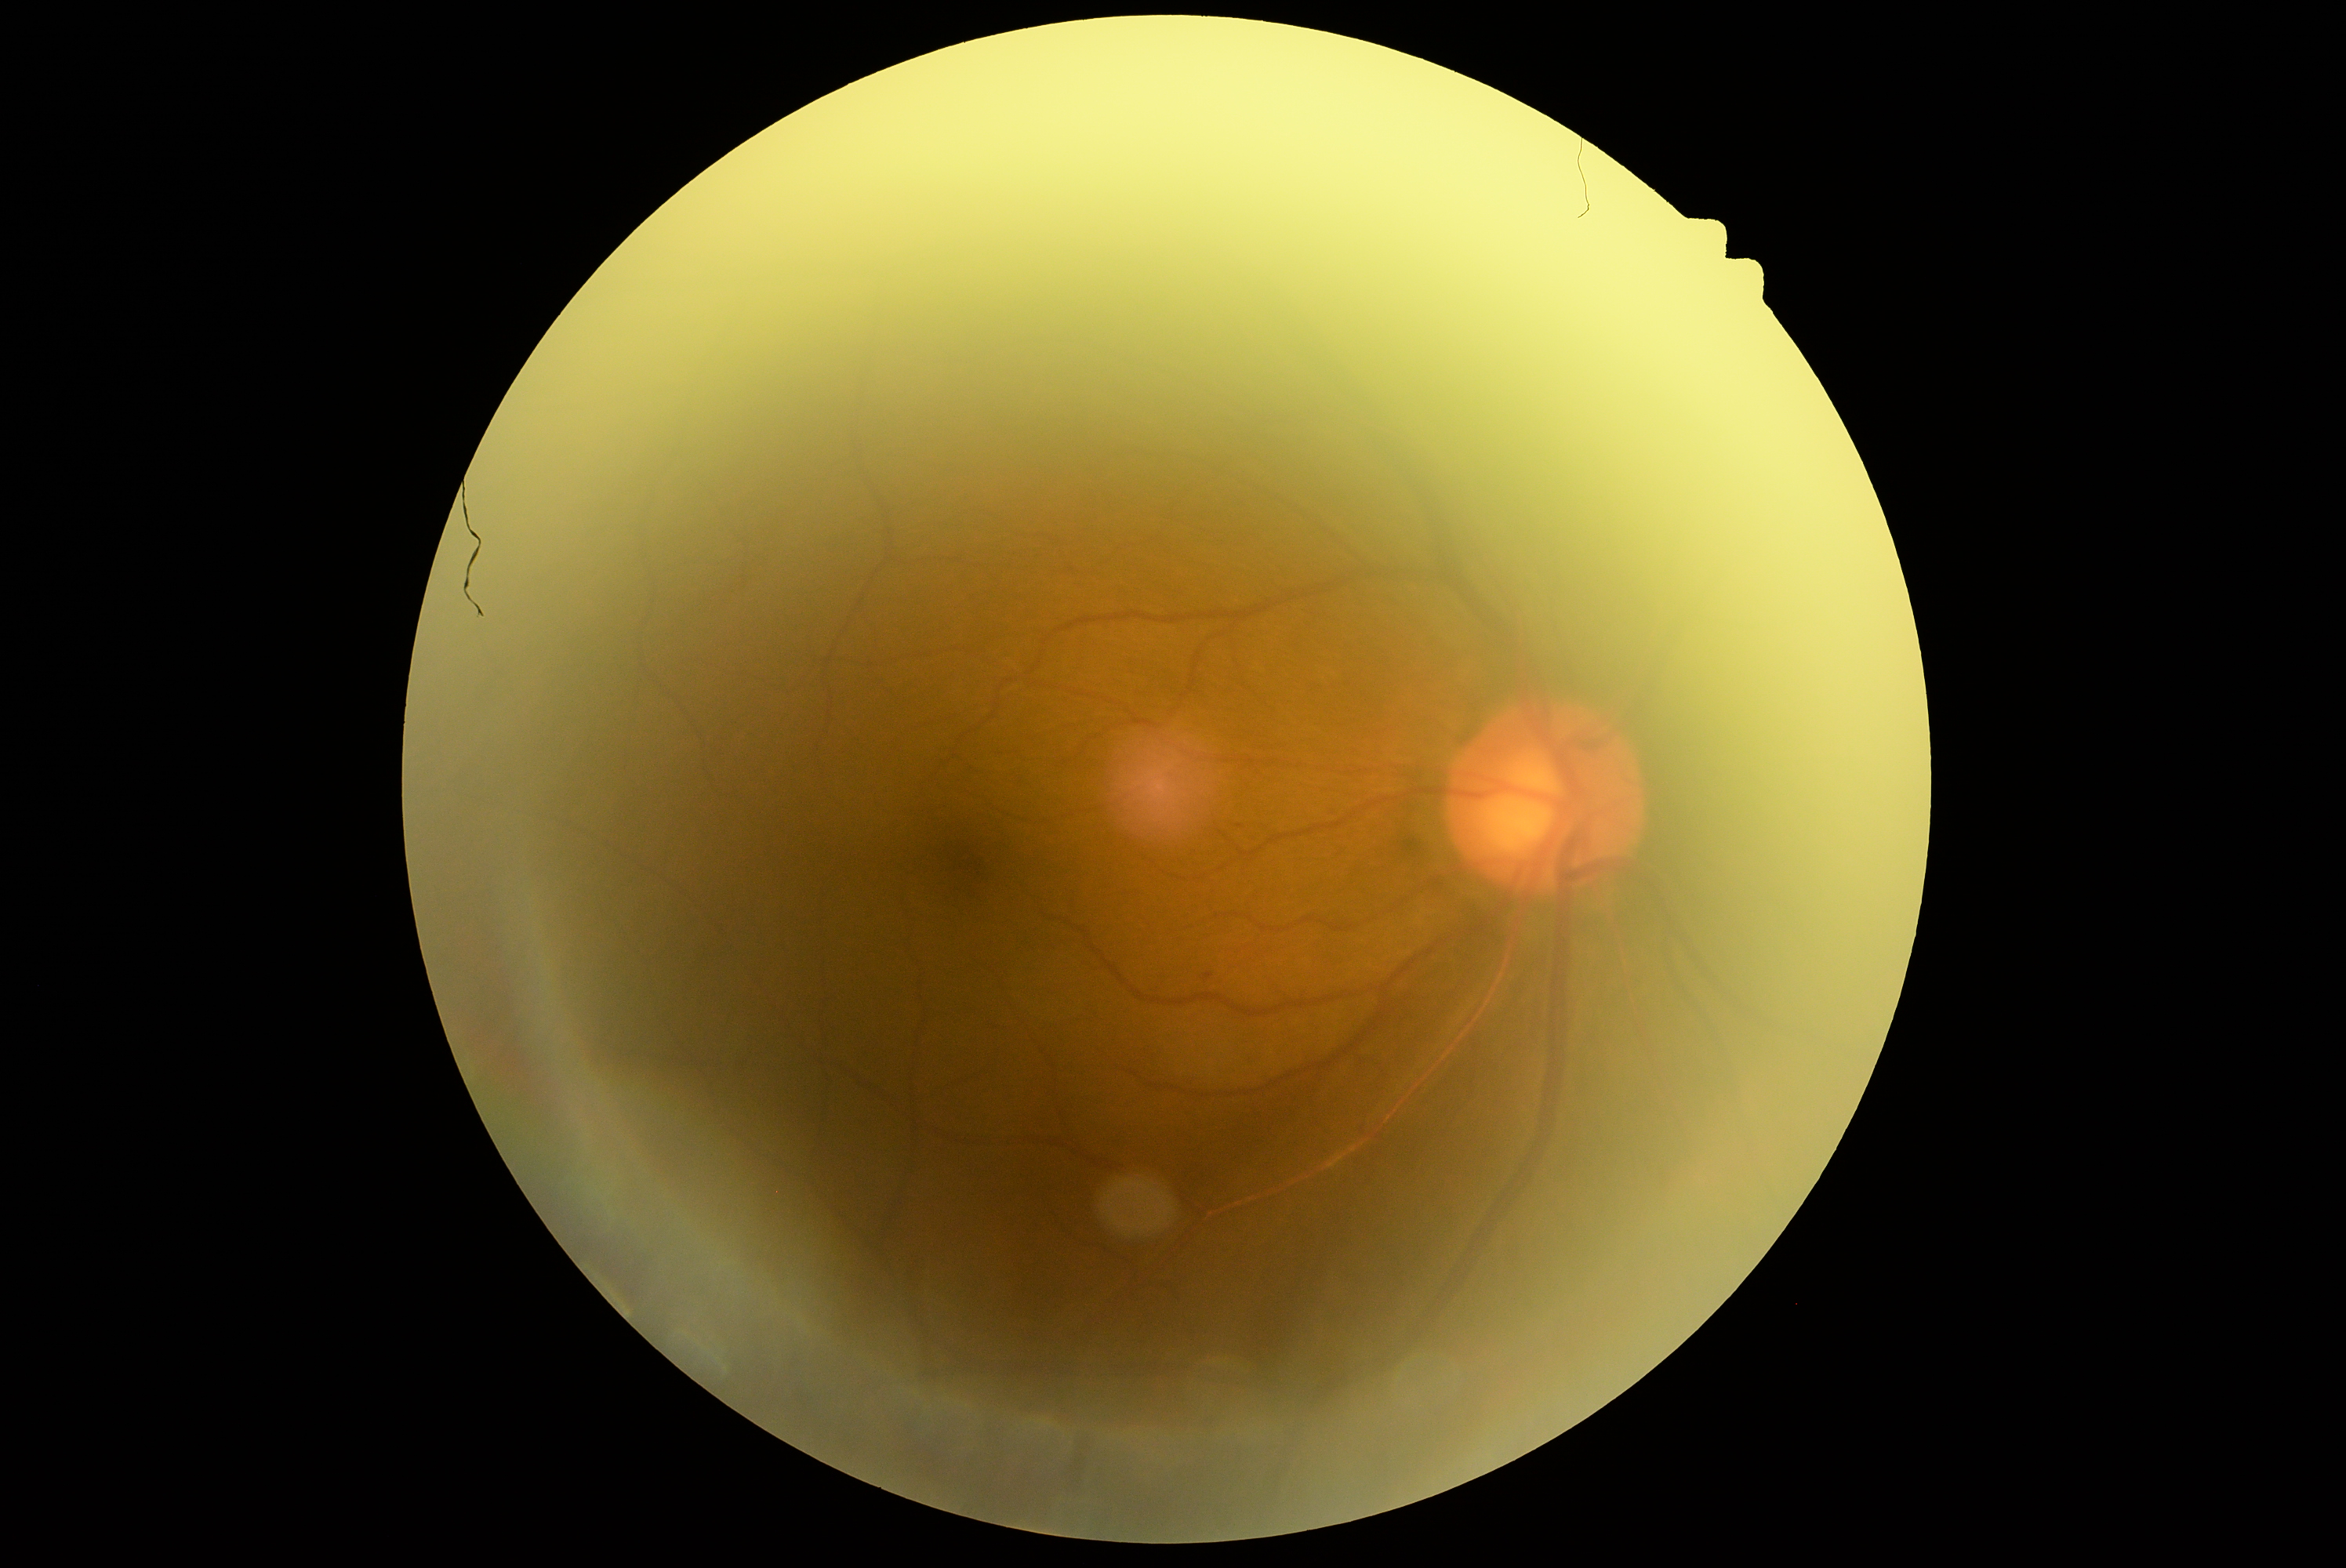

DR severity is grade 1 (mild NPDR).